1932x1932 · retinal fundus photograph:
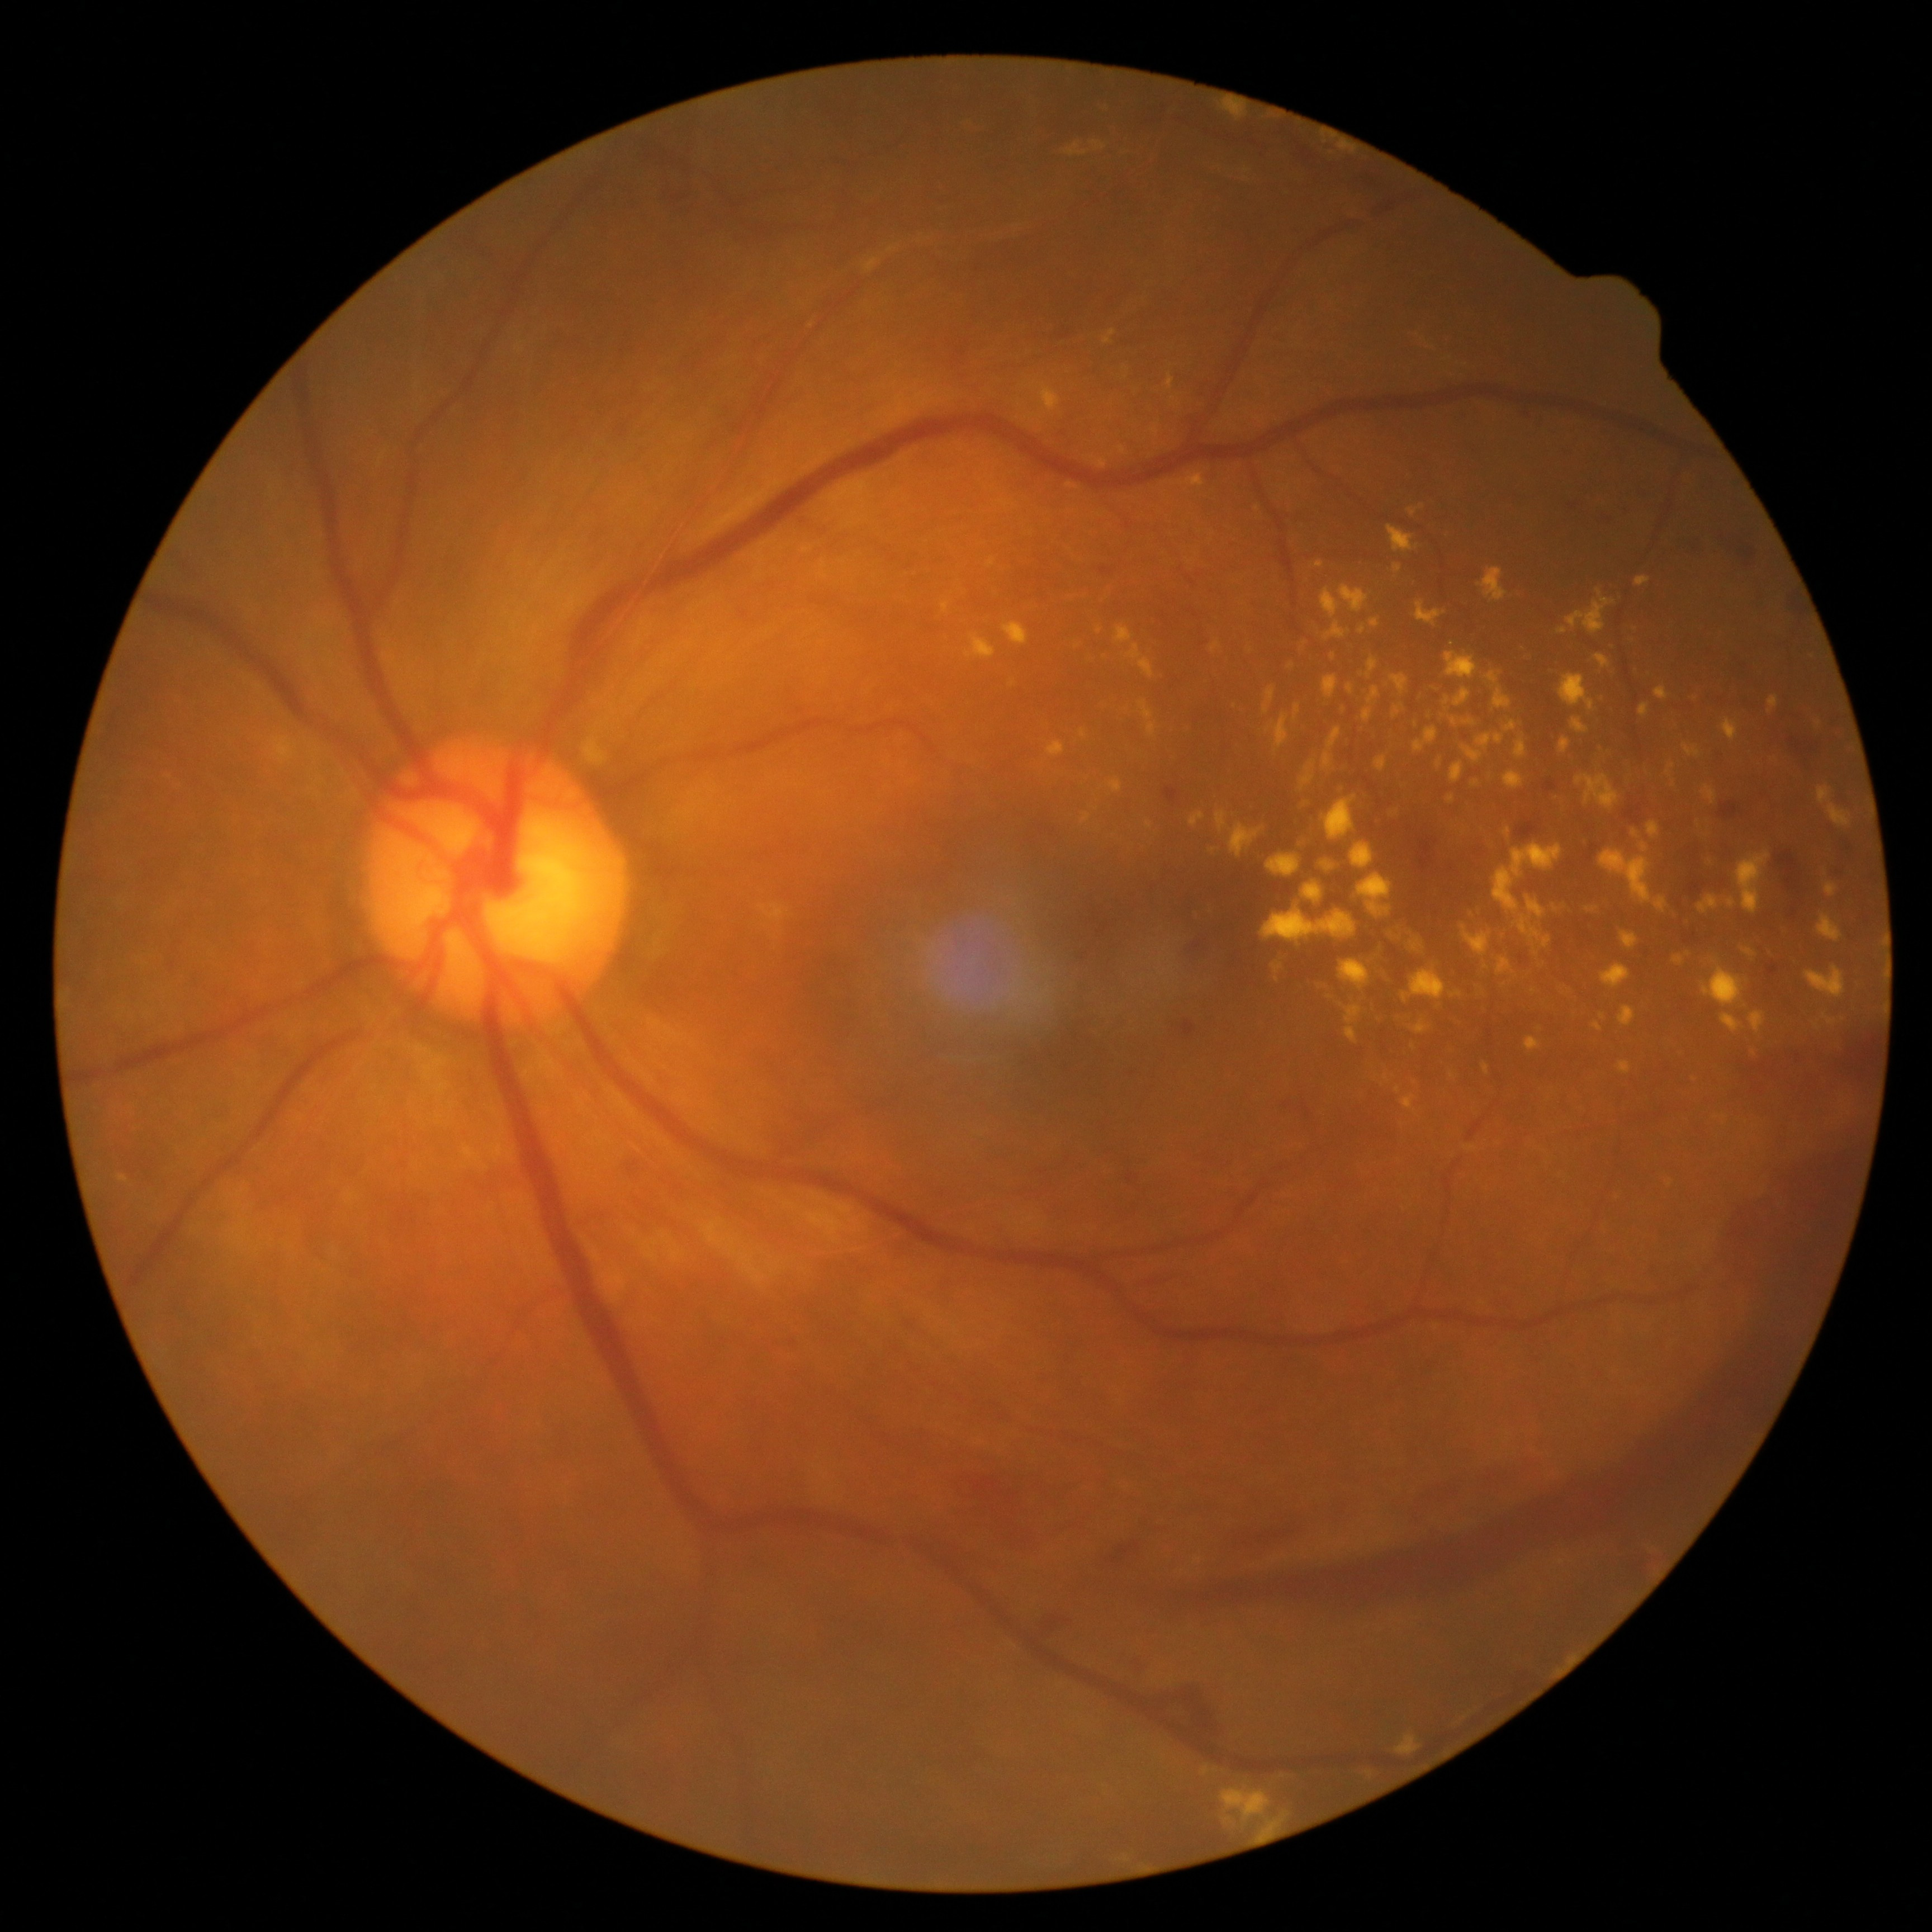
Diabetic retinopathy (DR) is grade 4 (PDR)
Selected lesions:
hard exudates (EXs) (subset): region(1560, 738, 1570, 754) | region(1504, 771, 1524, 791) | region(1483, 1062, 1490, 1076) | region(1486, 671, 1511, 709) | region(1516, 738, 1528, 760) | region(1498, 955, 1513, 976) | region(1202, 1766, 1209, 1775) | region(1294, 704, 1301, 722) | region(1409, 505, 1425, 517) | region(1267, 855, 1301, 877) | region(1472, 780, 1481, 789) | region(1499, 923, 1510, 943) | region(1323, 676, 1339, 698) | region(1567, 589, 1616, 634) | region(1418, 685, 1445, 706) | region(1817, 787, 1851, 828)
EXs (small, approximate centers) near (1387,1079) | (1371,1774) | (1695,1080) | (1818,1027)